Wide-field fundus photograph of an infant: 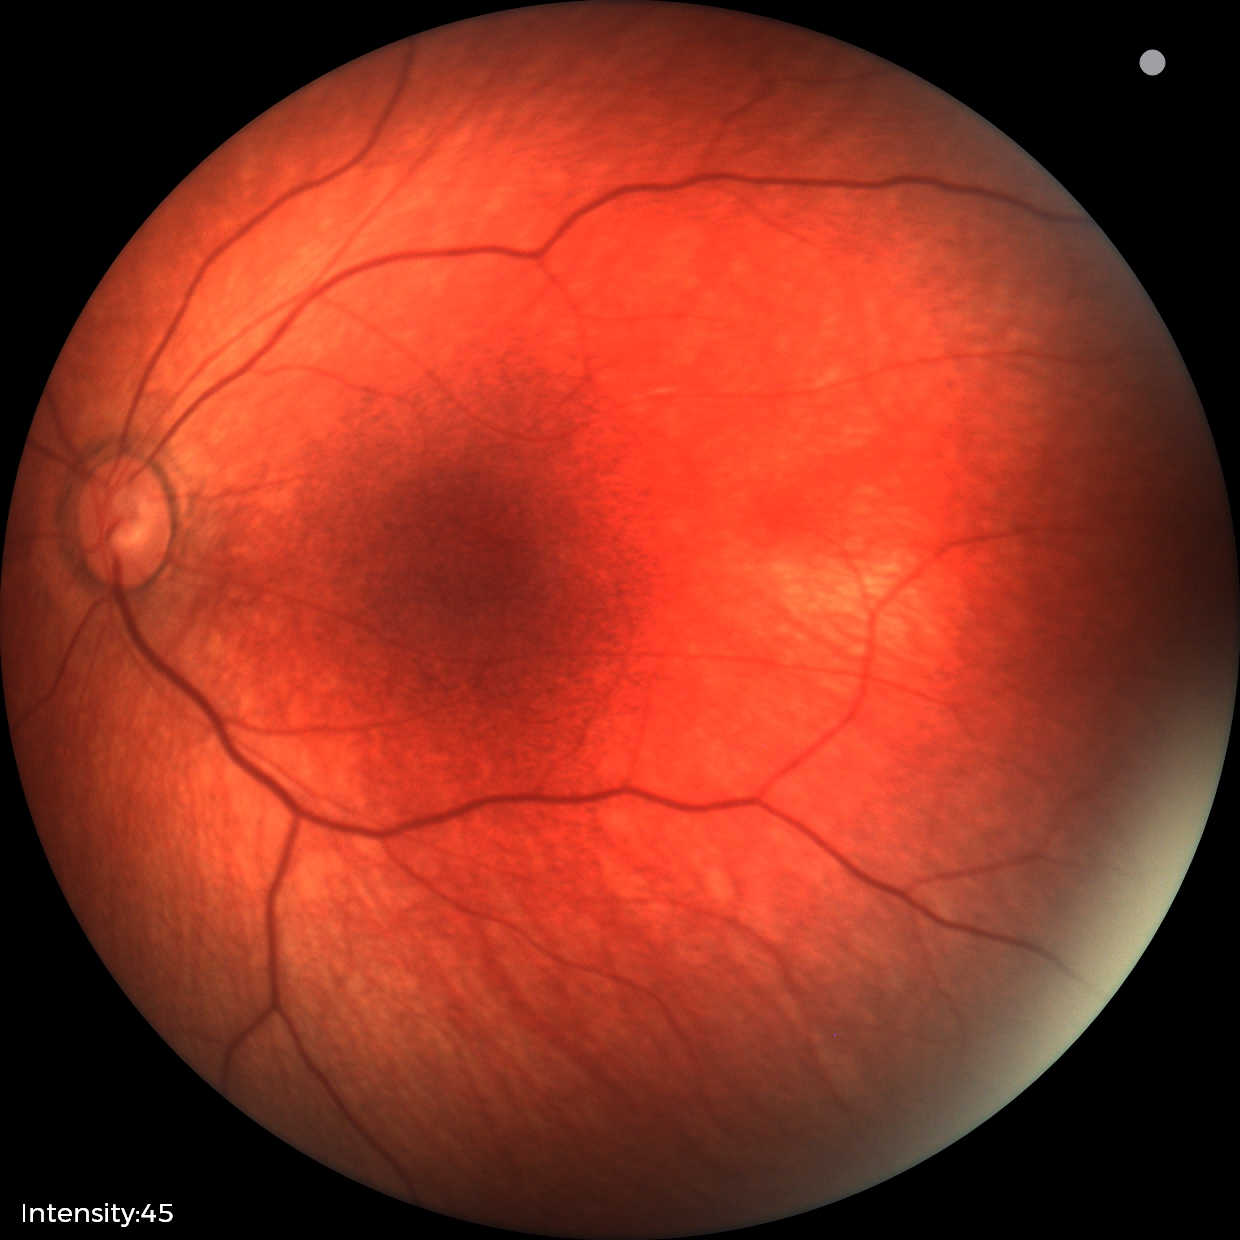

No retinal pathology identified on screening.